Pediatric retinal photograph (wide-field).
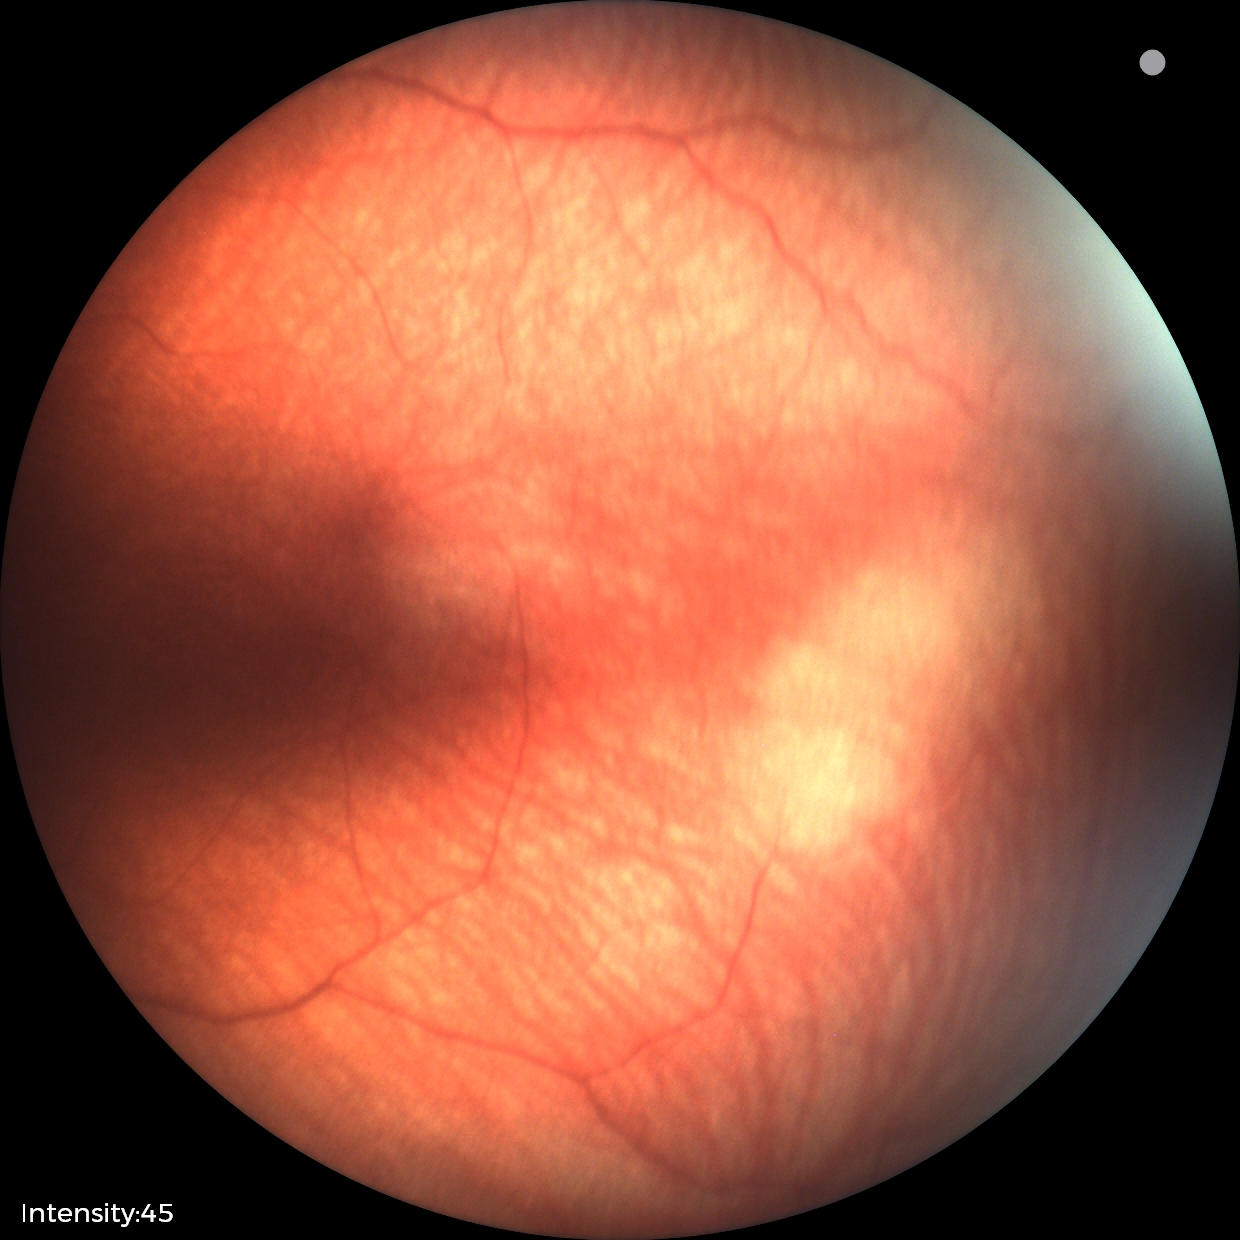 Screening examination with no abnormal retinal findings.